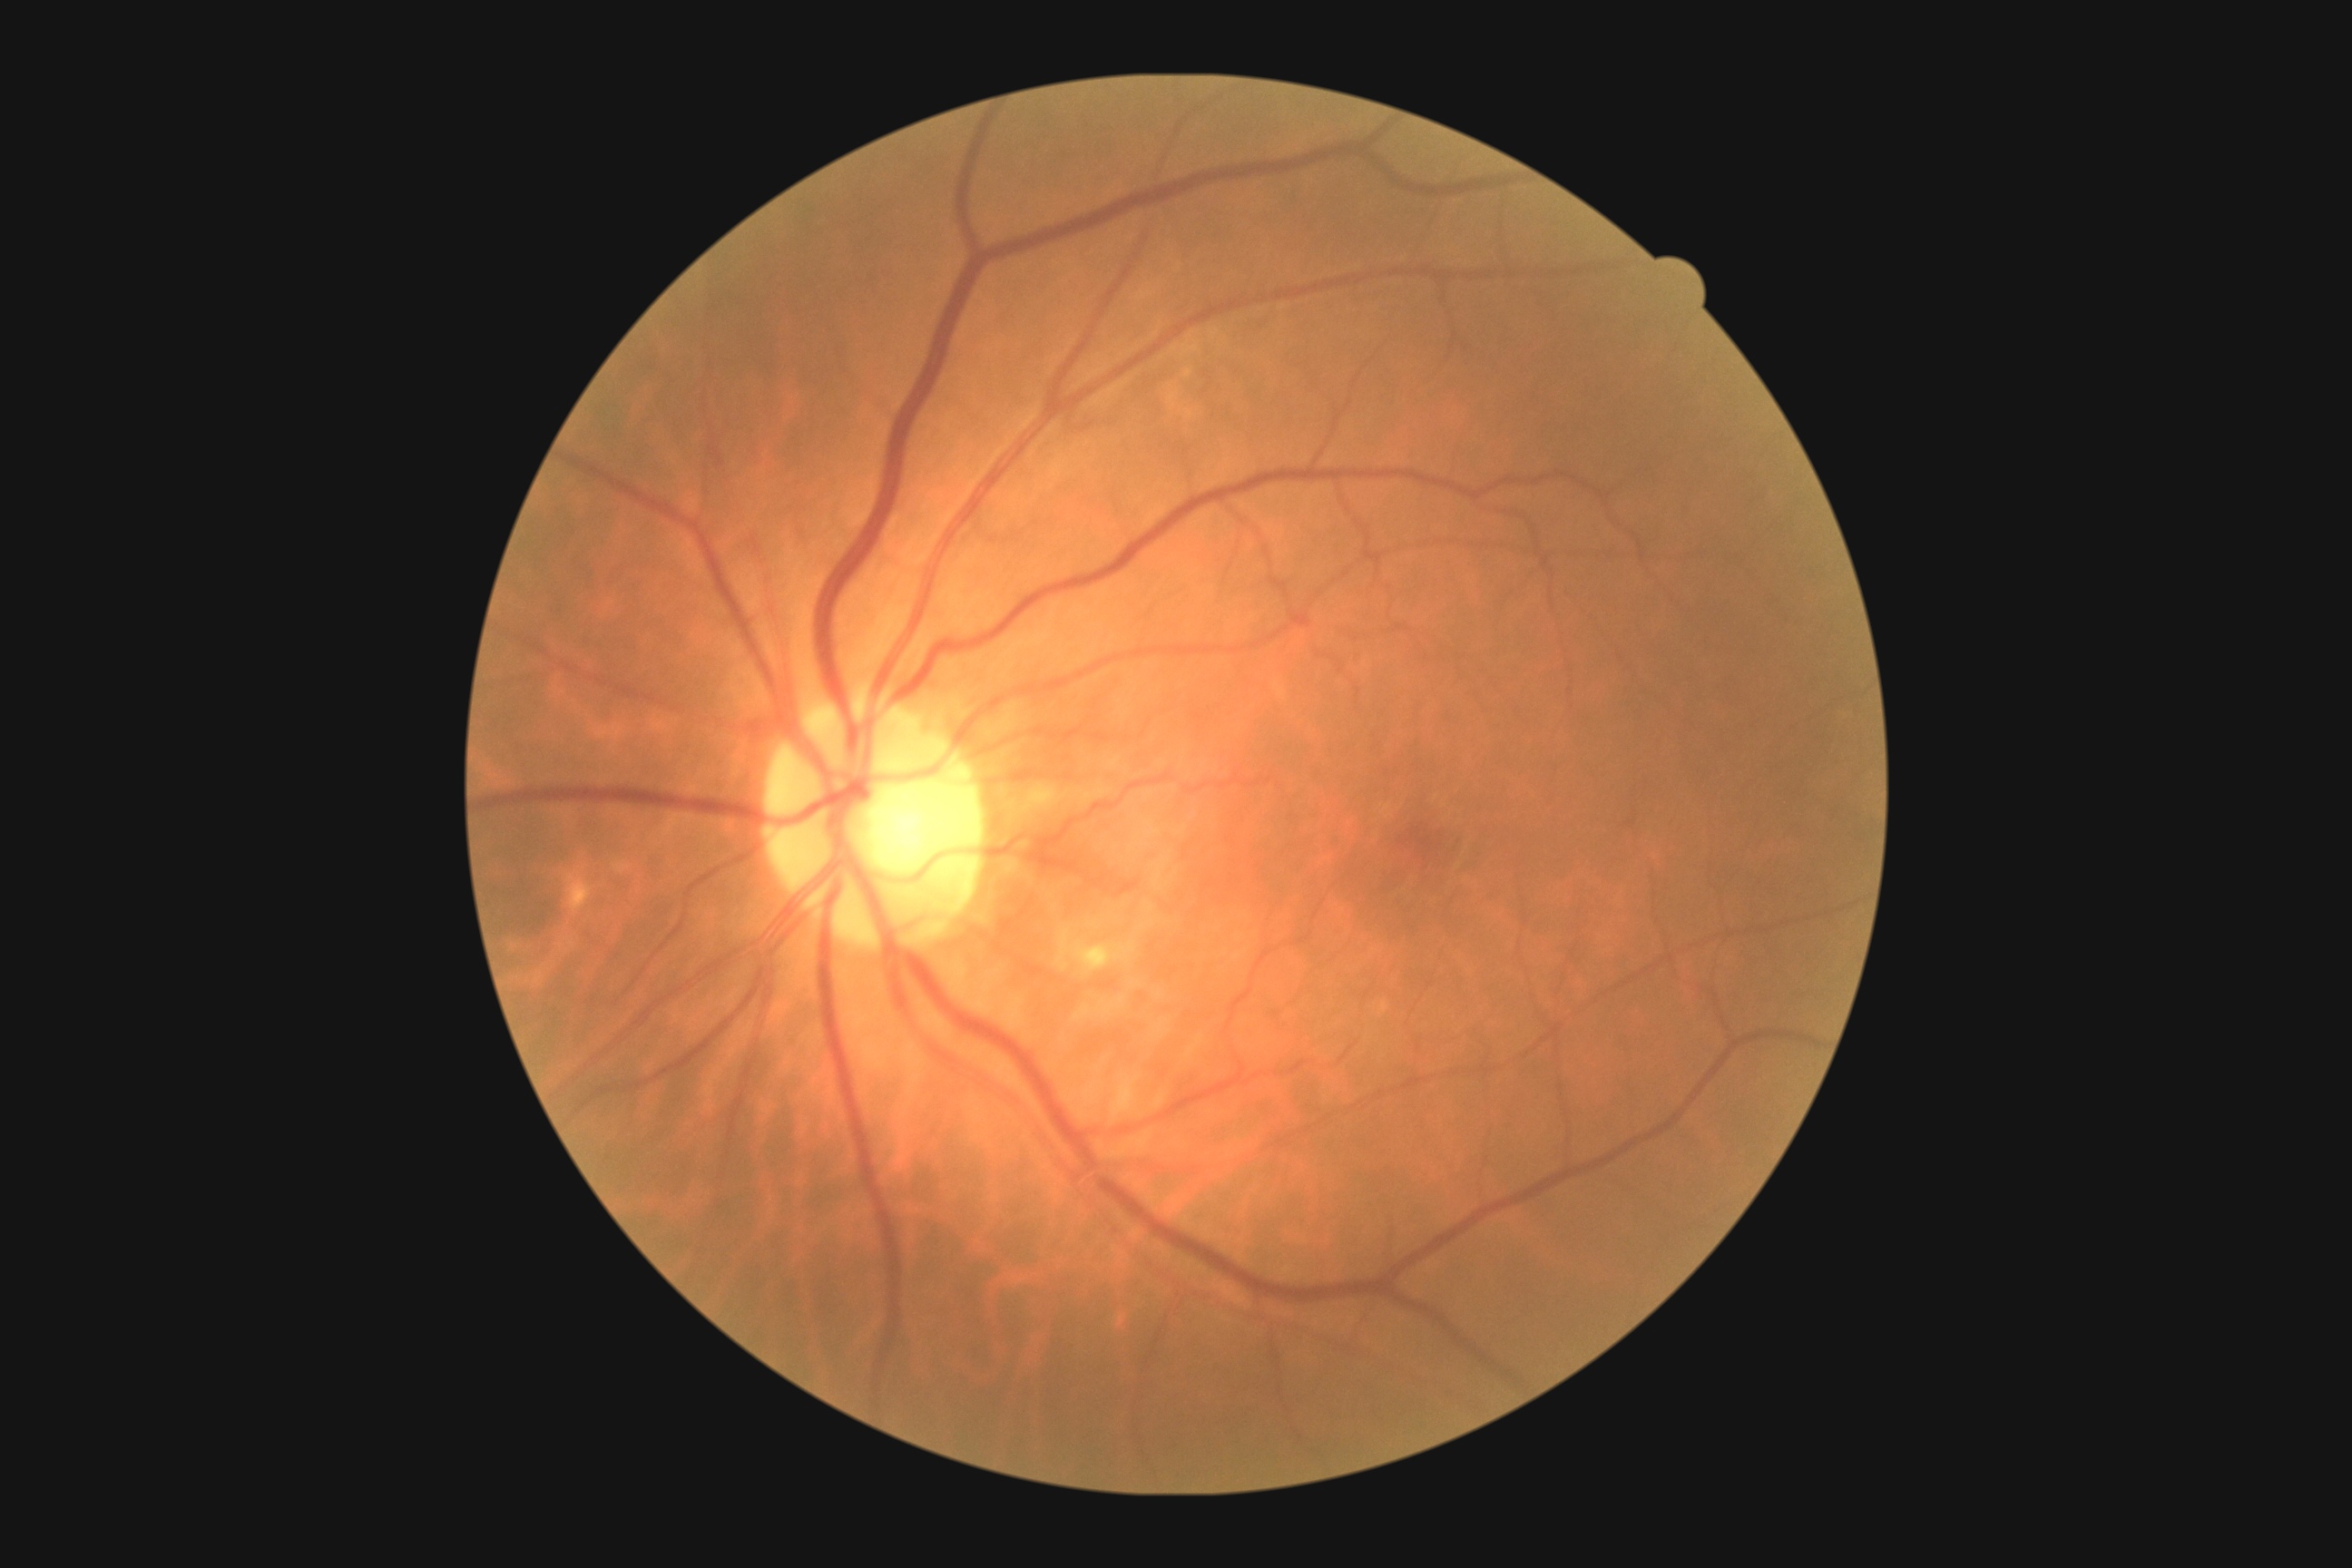 Findings:
– DR impression — no apparent DR
– DR — 0/4